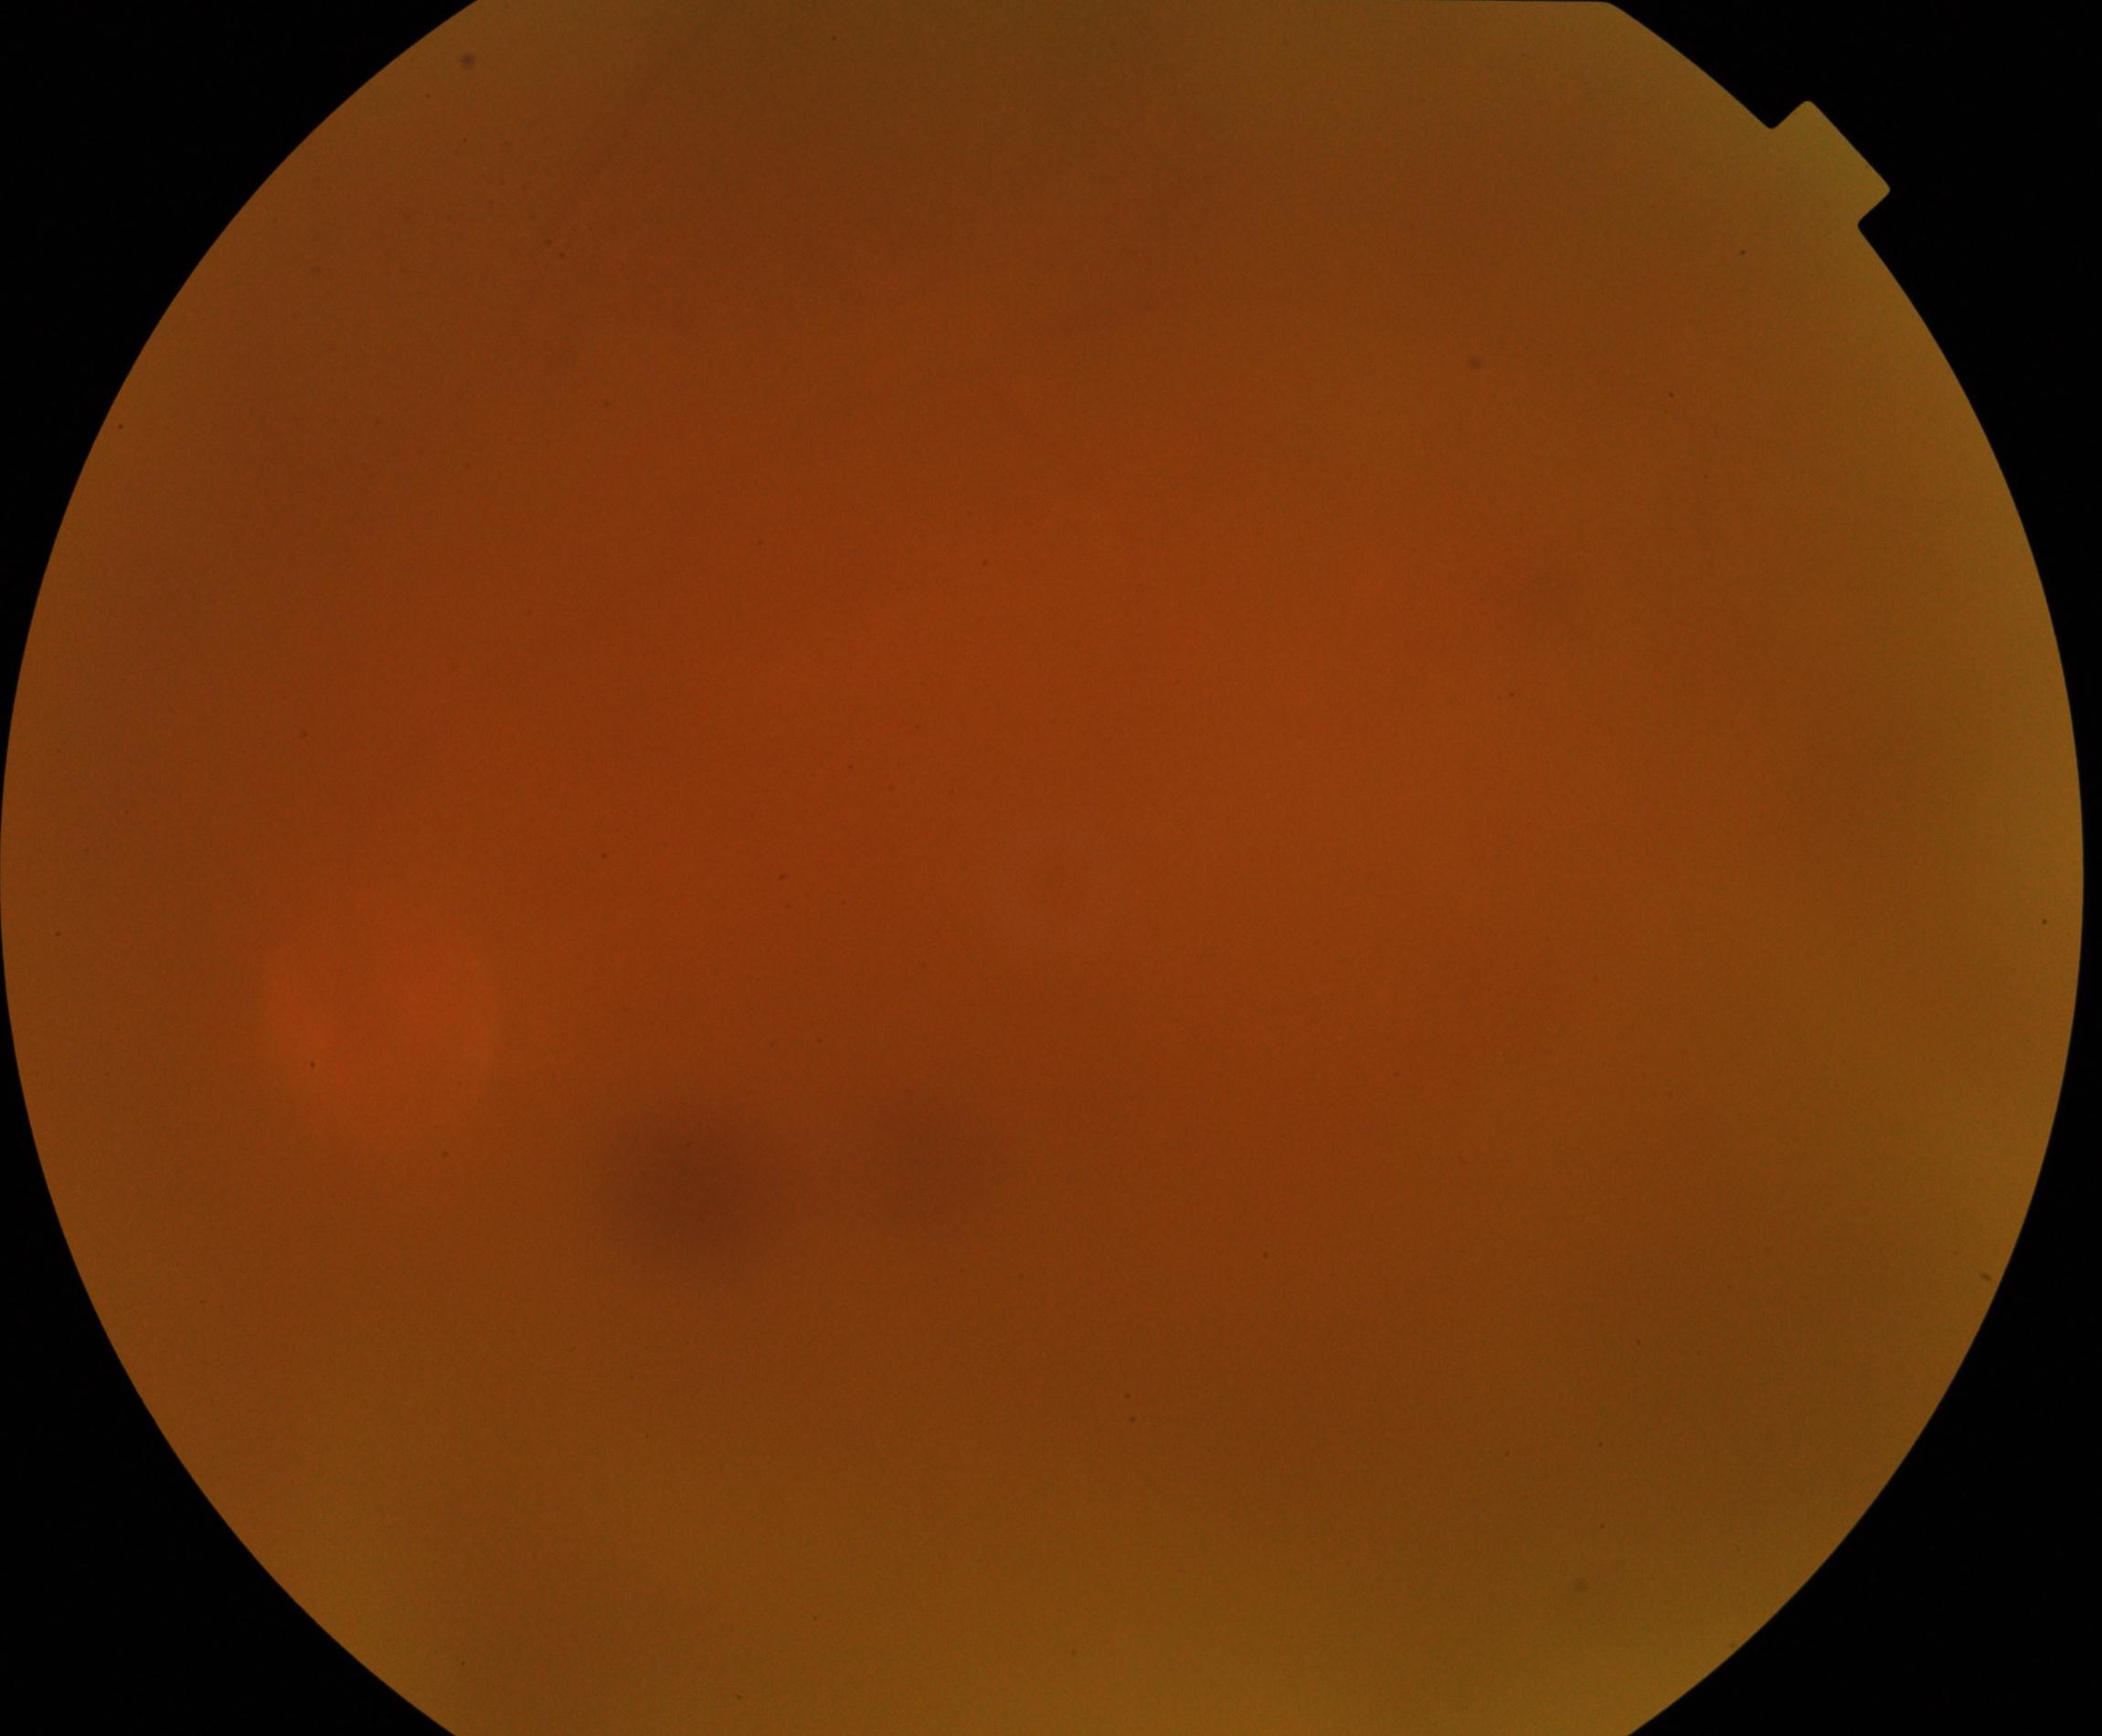 Image quality: blurred, more than half the field obscured. Proliferative retinopathy: not identified.